Color fundus image · modified Davis classification · 848 by 848 pixels: 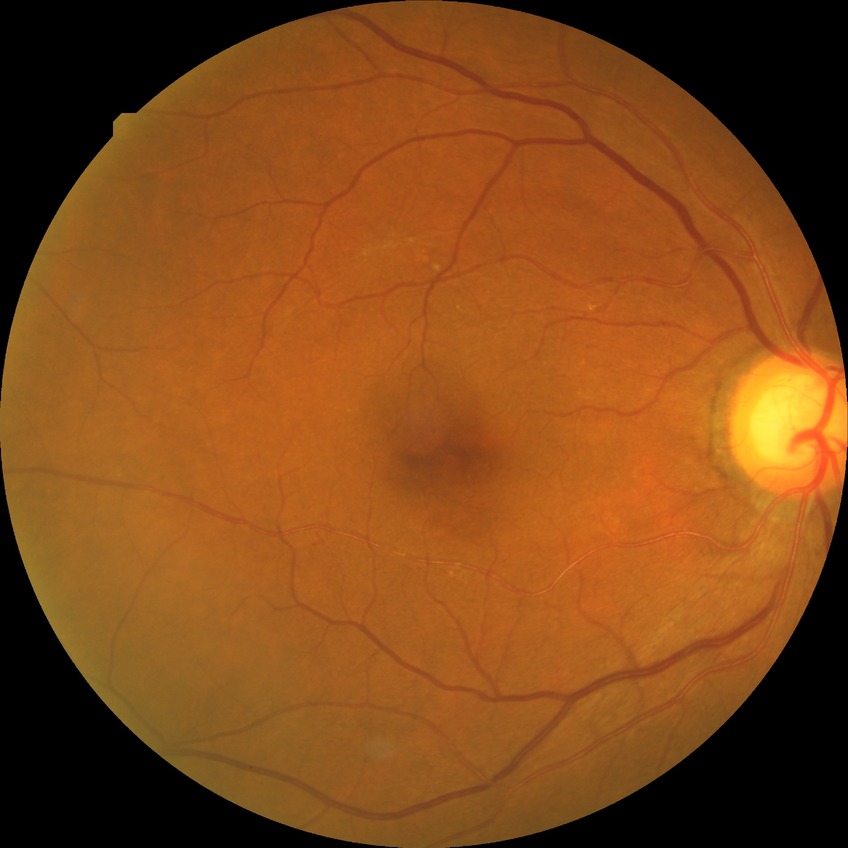

Diabetic retinopathy grade: no diabetic retinopathy.